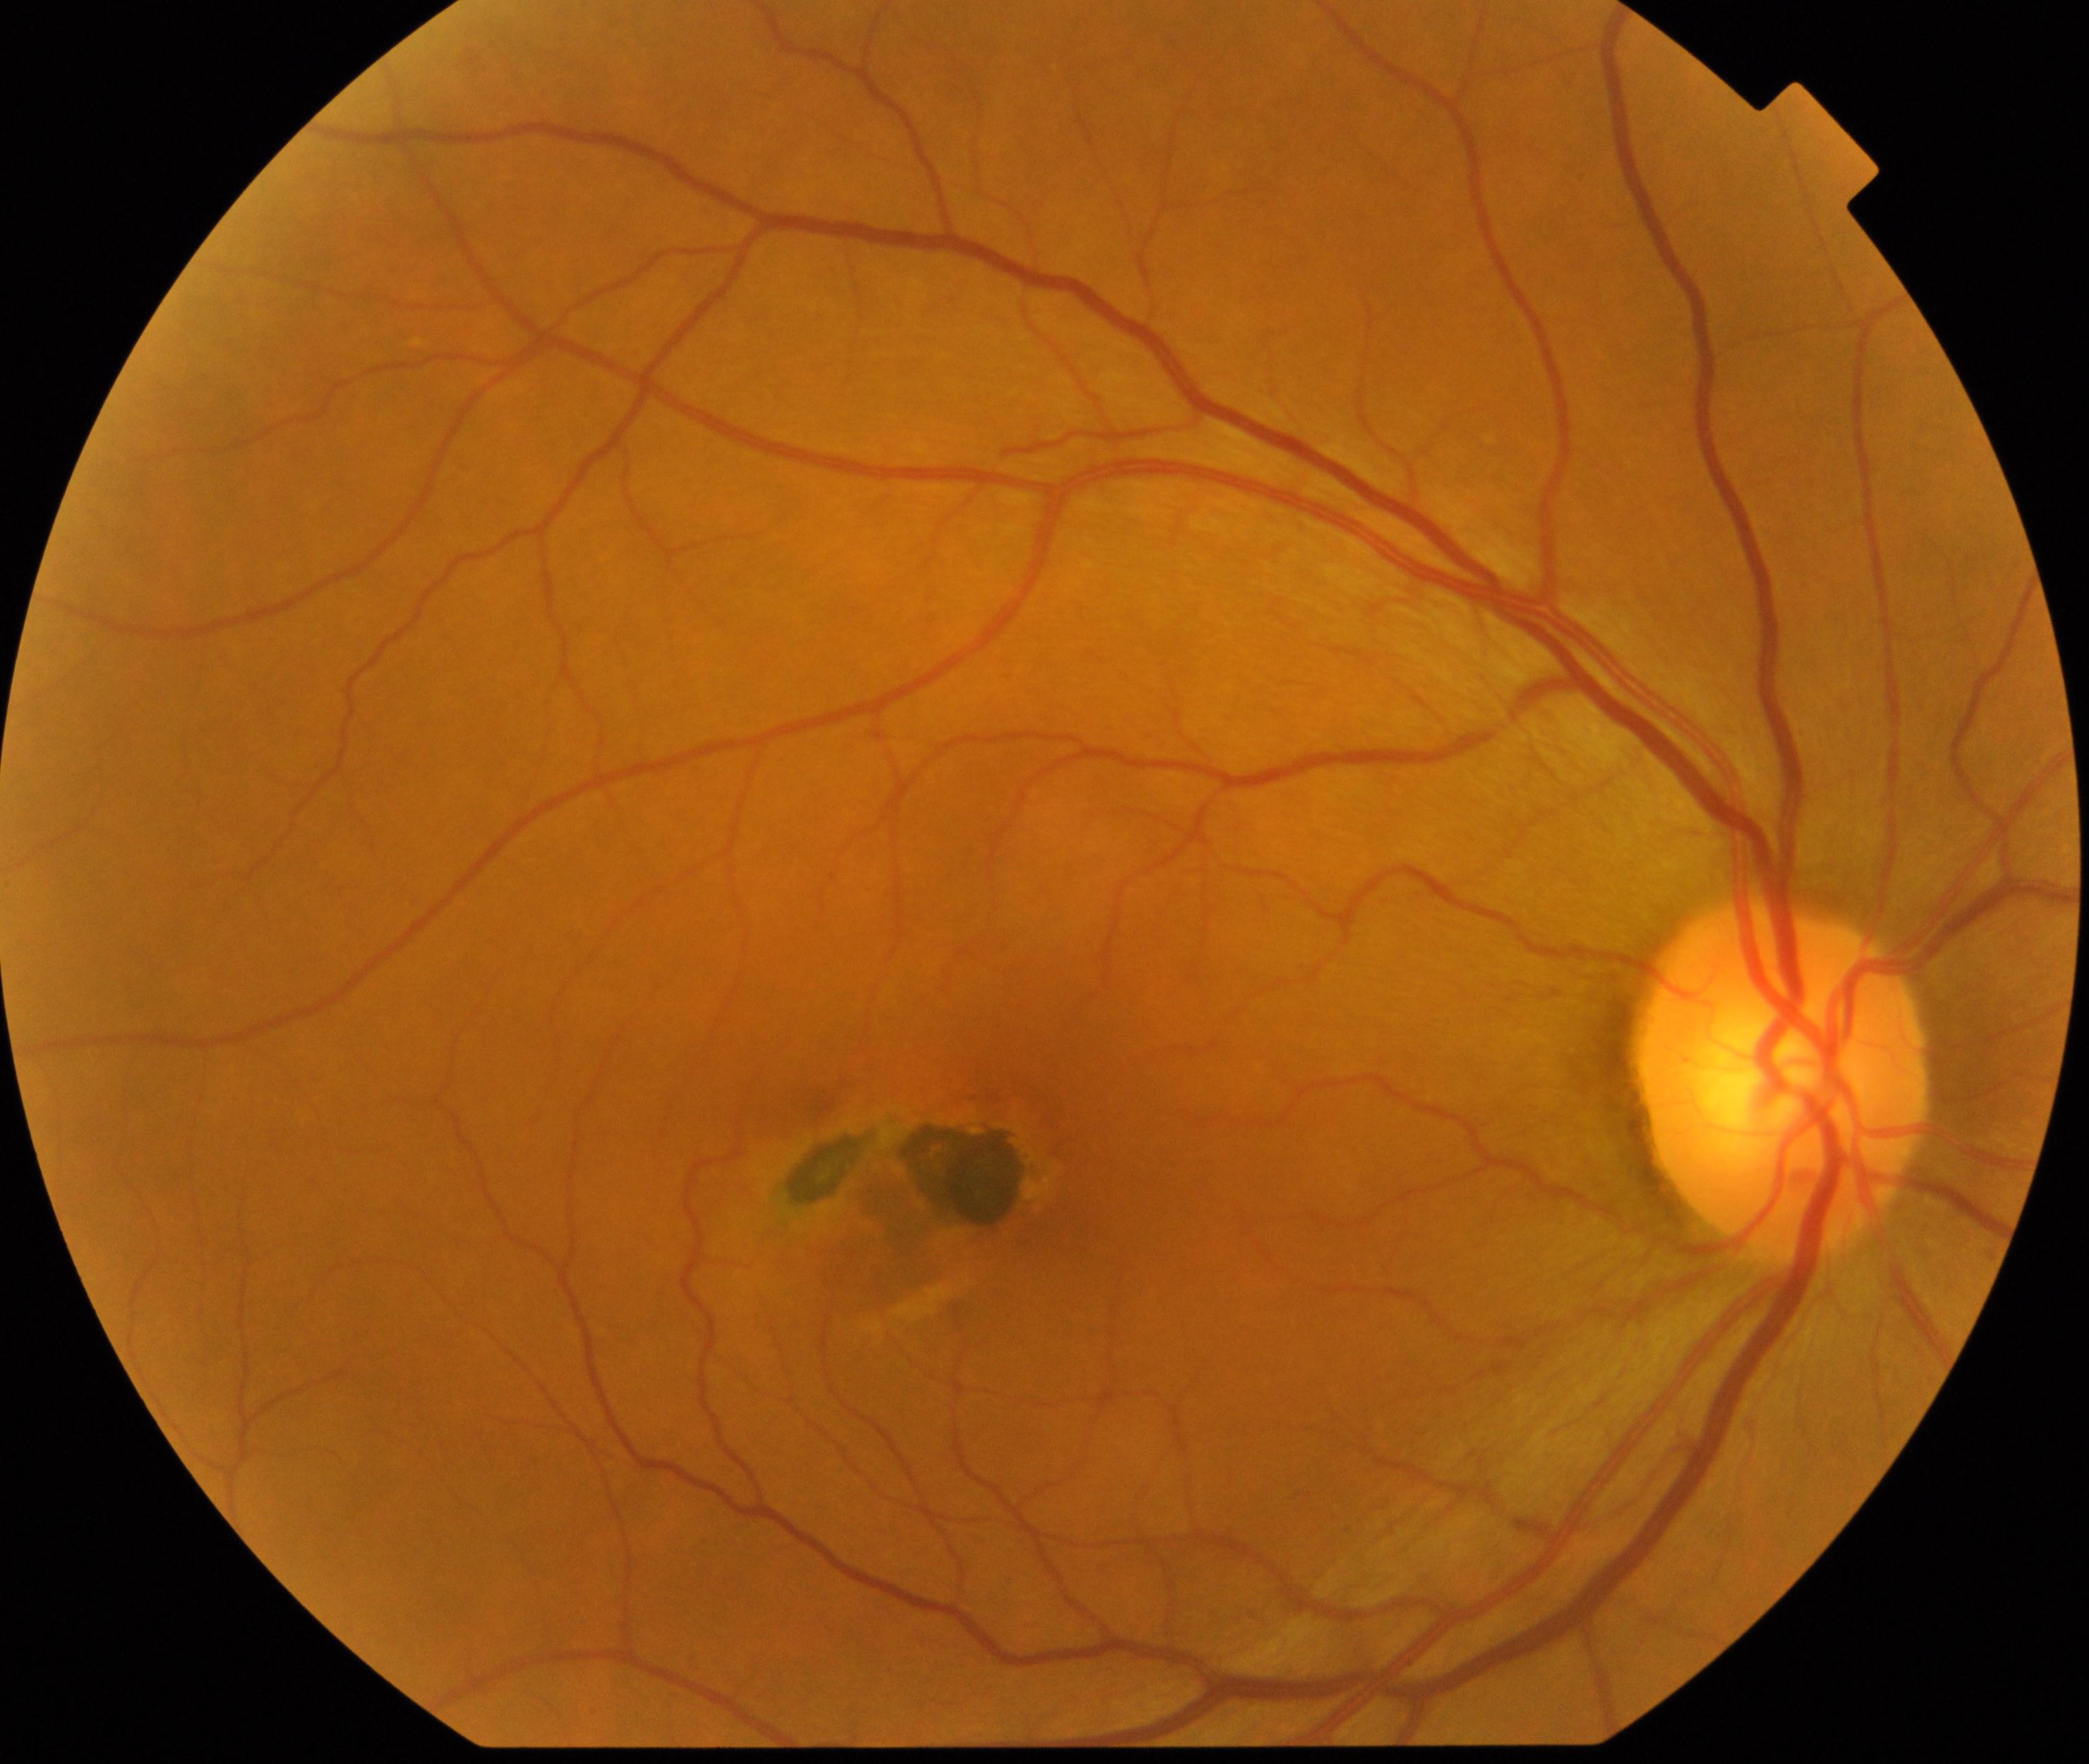 Findings: maculopathy. Characterized by lesions within the macular area, such as intermediate or neovascular age-related macular degeneration, retinal angiomatous proliferation, polypoidal choroidal vasculopathy, choroidal neovascularization, idiopathic macular telangiectasia, and macular atrophy, not caused by other listed disease categories.